Camera: Phoenix ICON (100° FOV). Wide-field fundus photograph of an infant. 1240 x 1240 pixels.
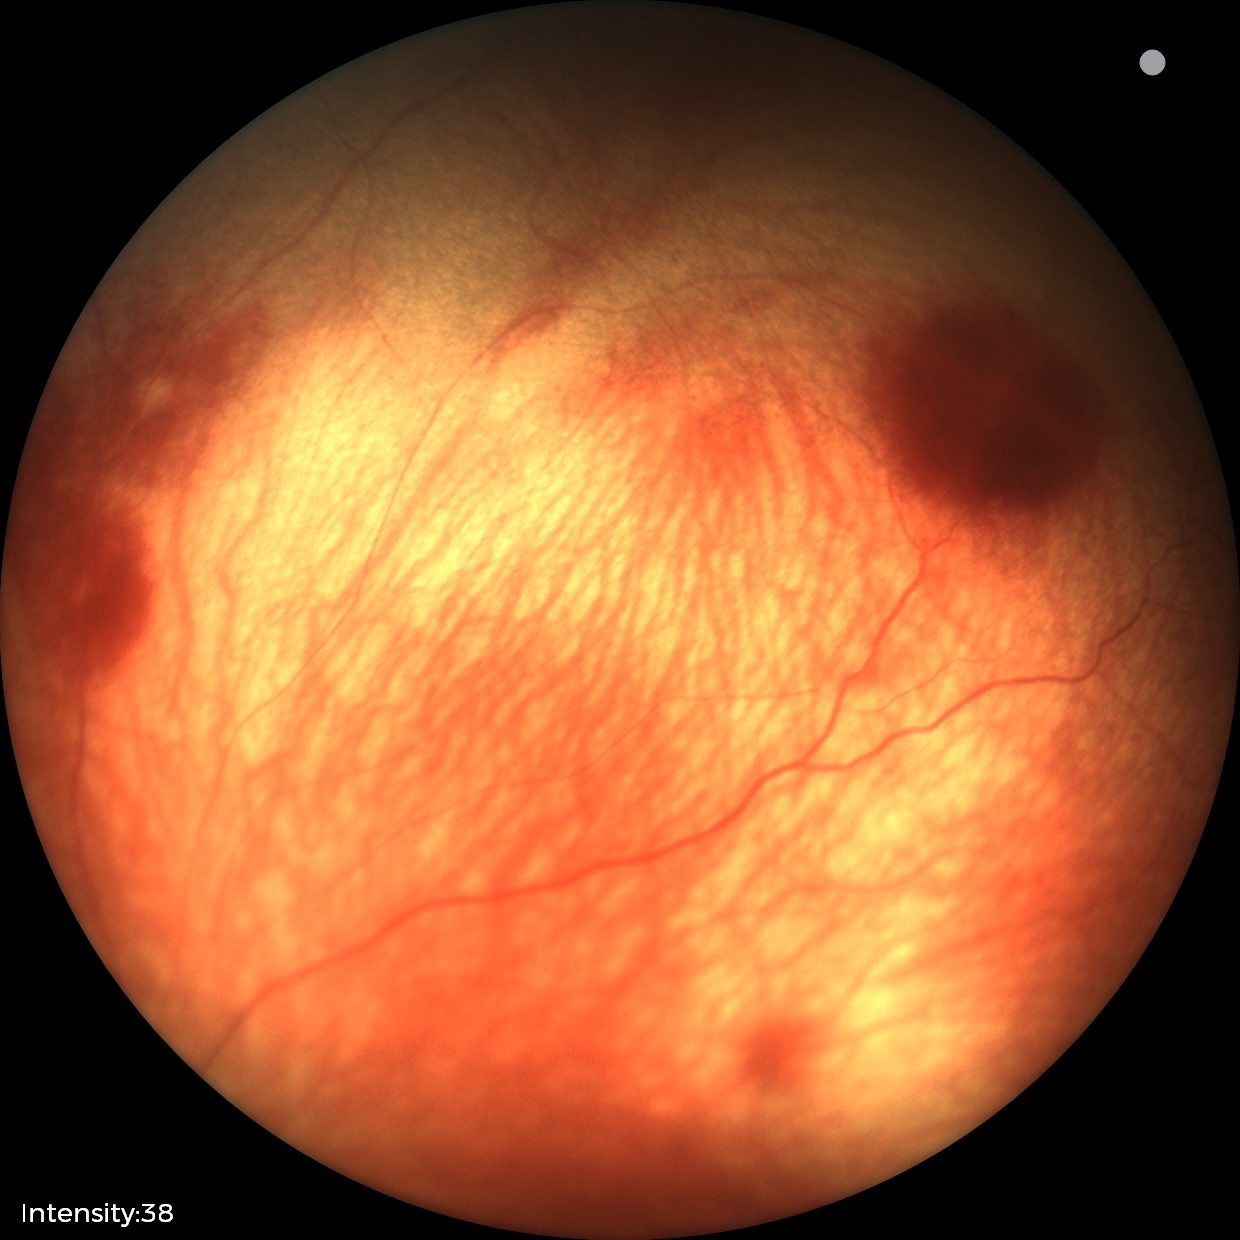
Screening examination consistent with retinal hemorrhages.